2212x1659px:
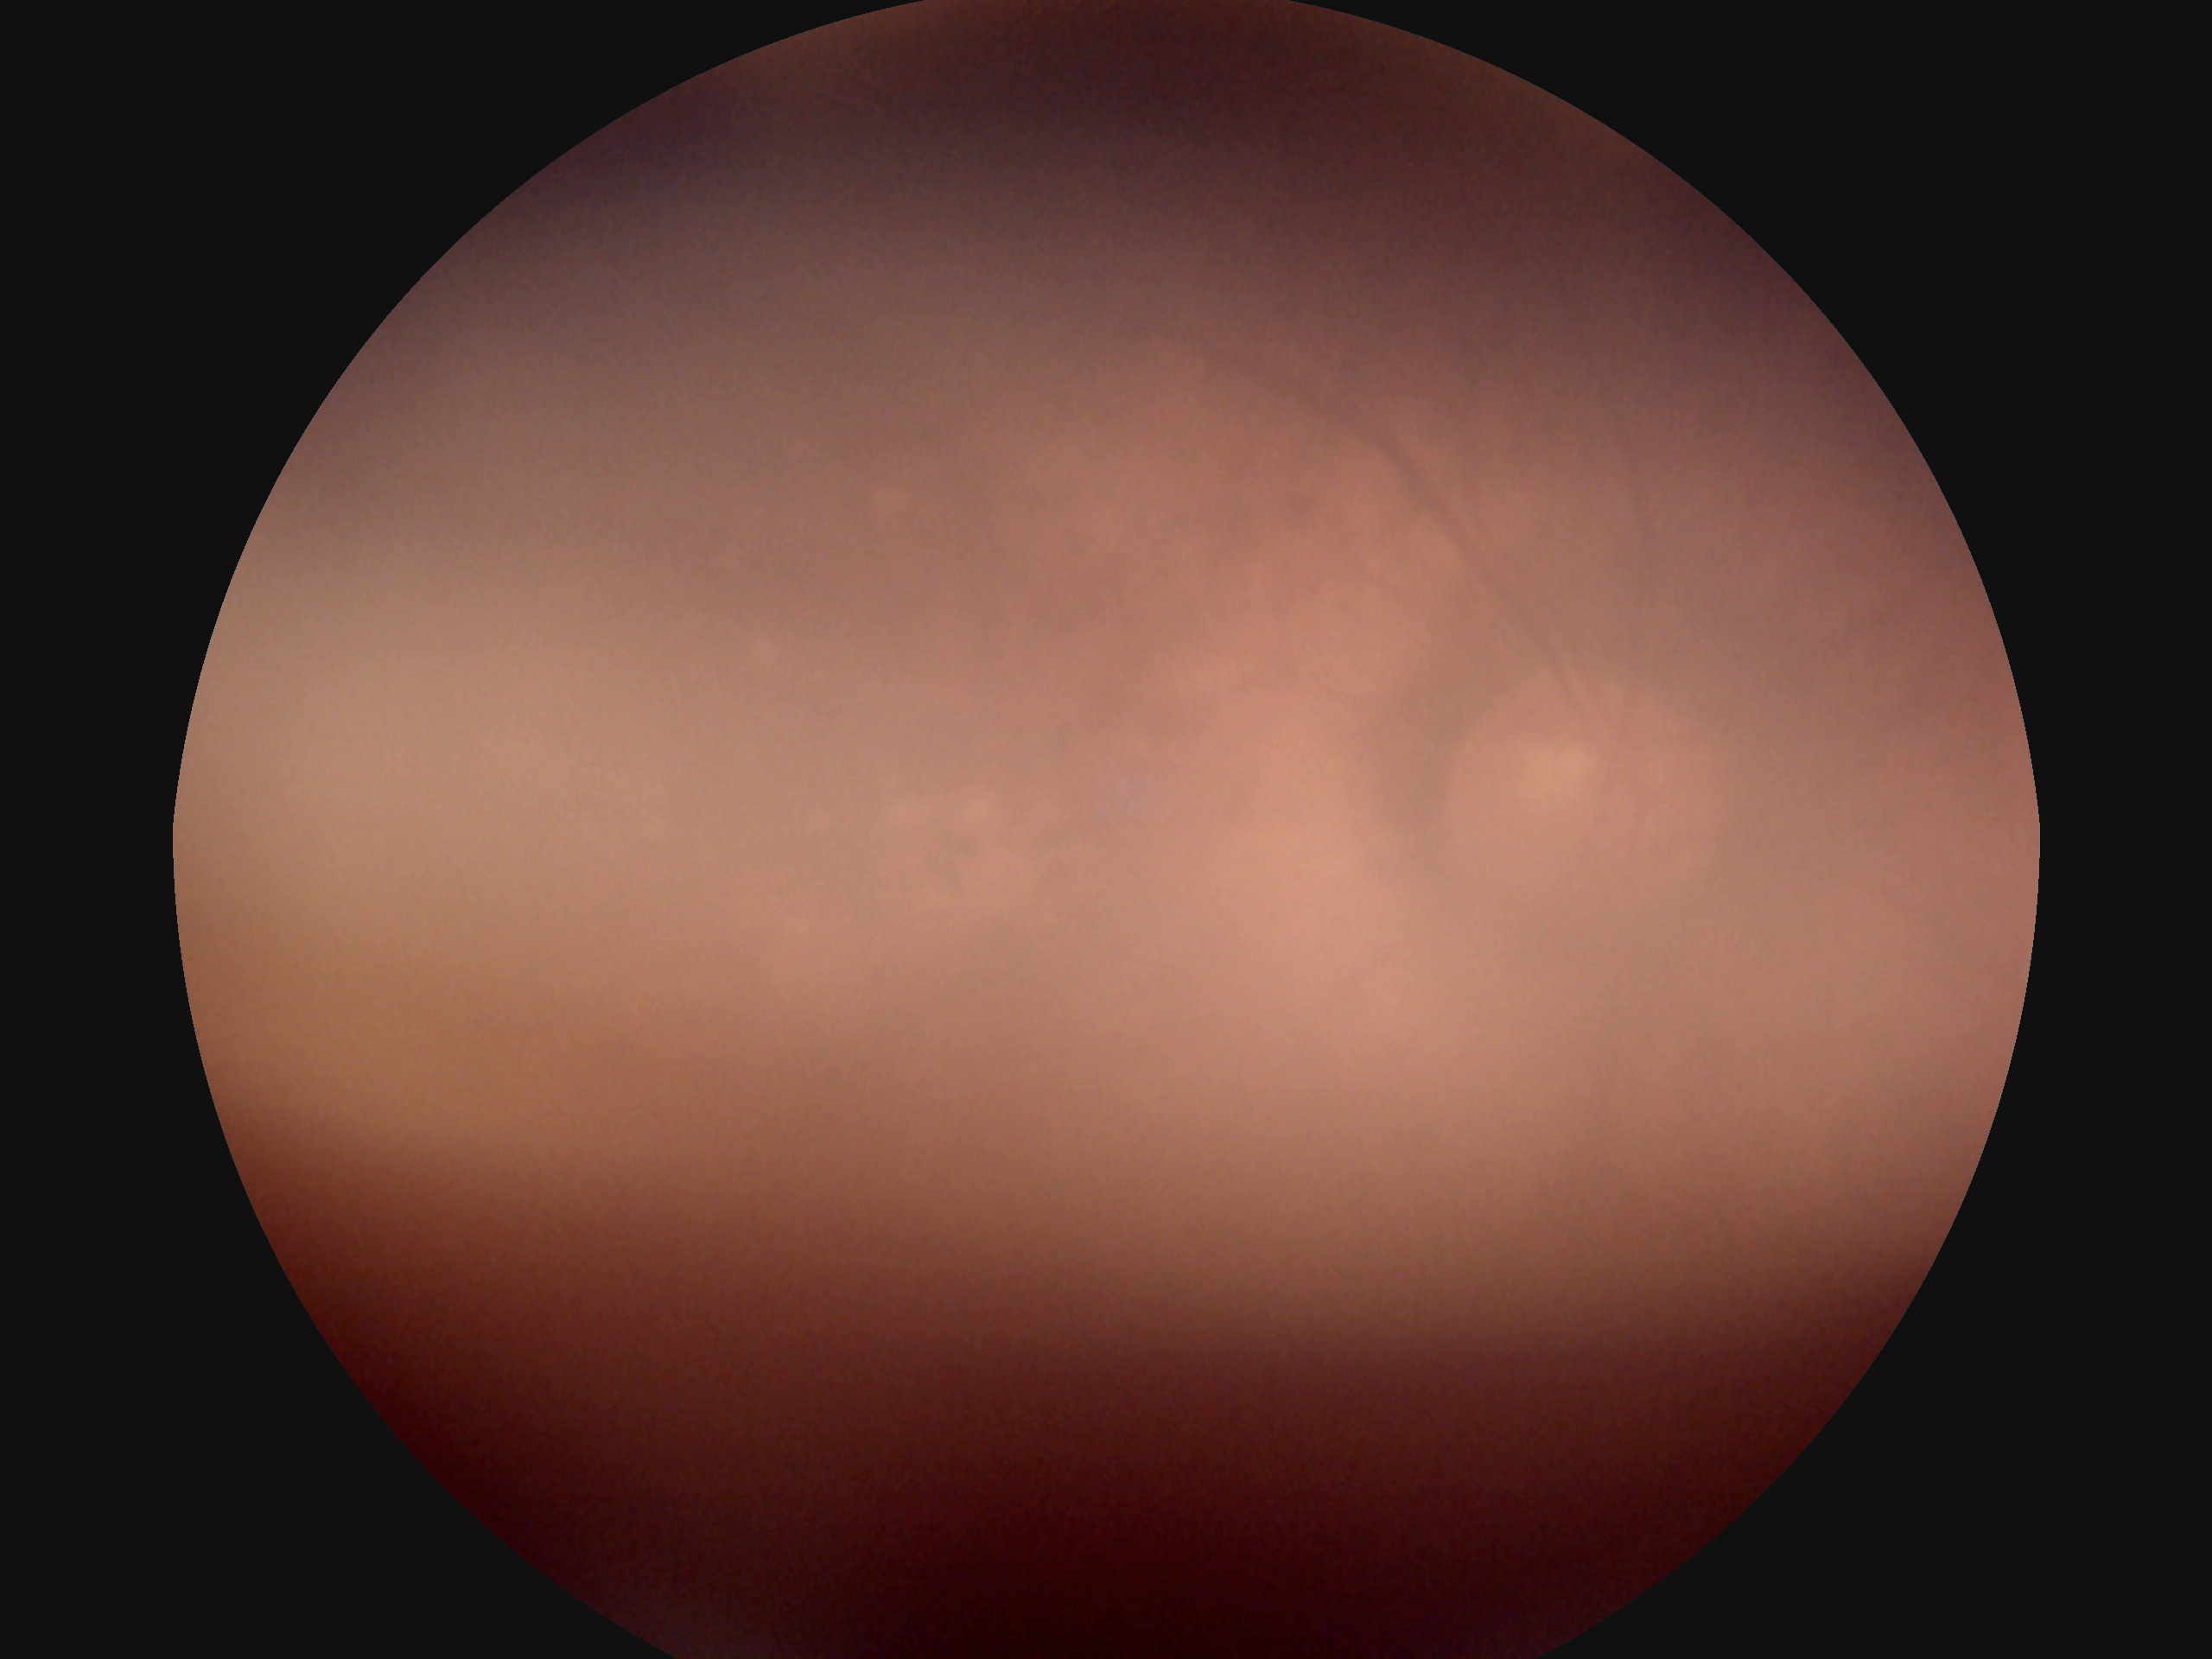

diabetic retinopathy grade: ungradable | image quality: insufficient for DR assessment.